848 by 848 pixels. Diabetic retinopathy graded by the modified Davis classification. No pharmacologic dilation — 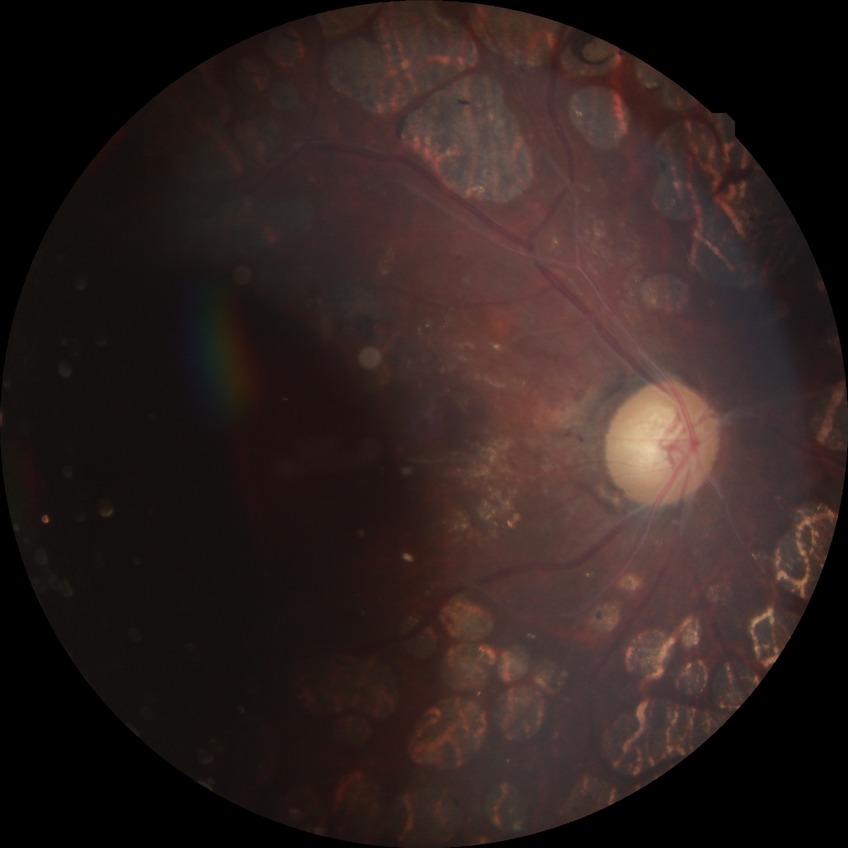 DR: PDR.